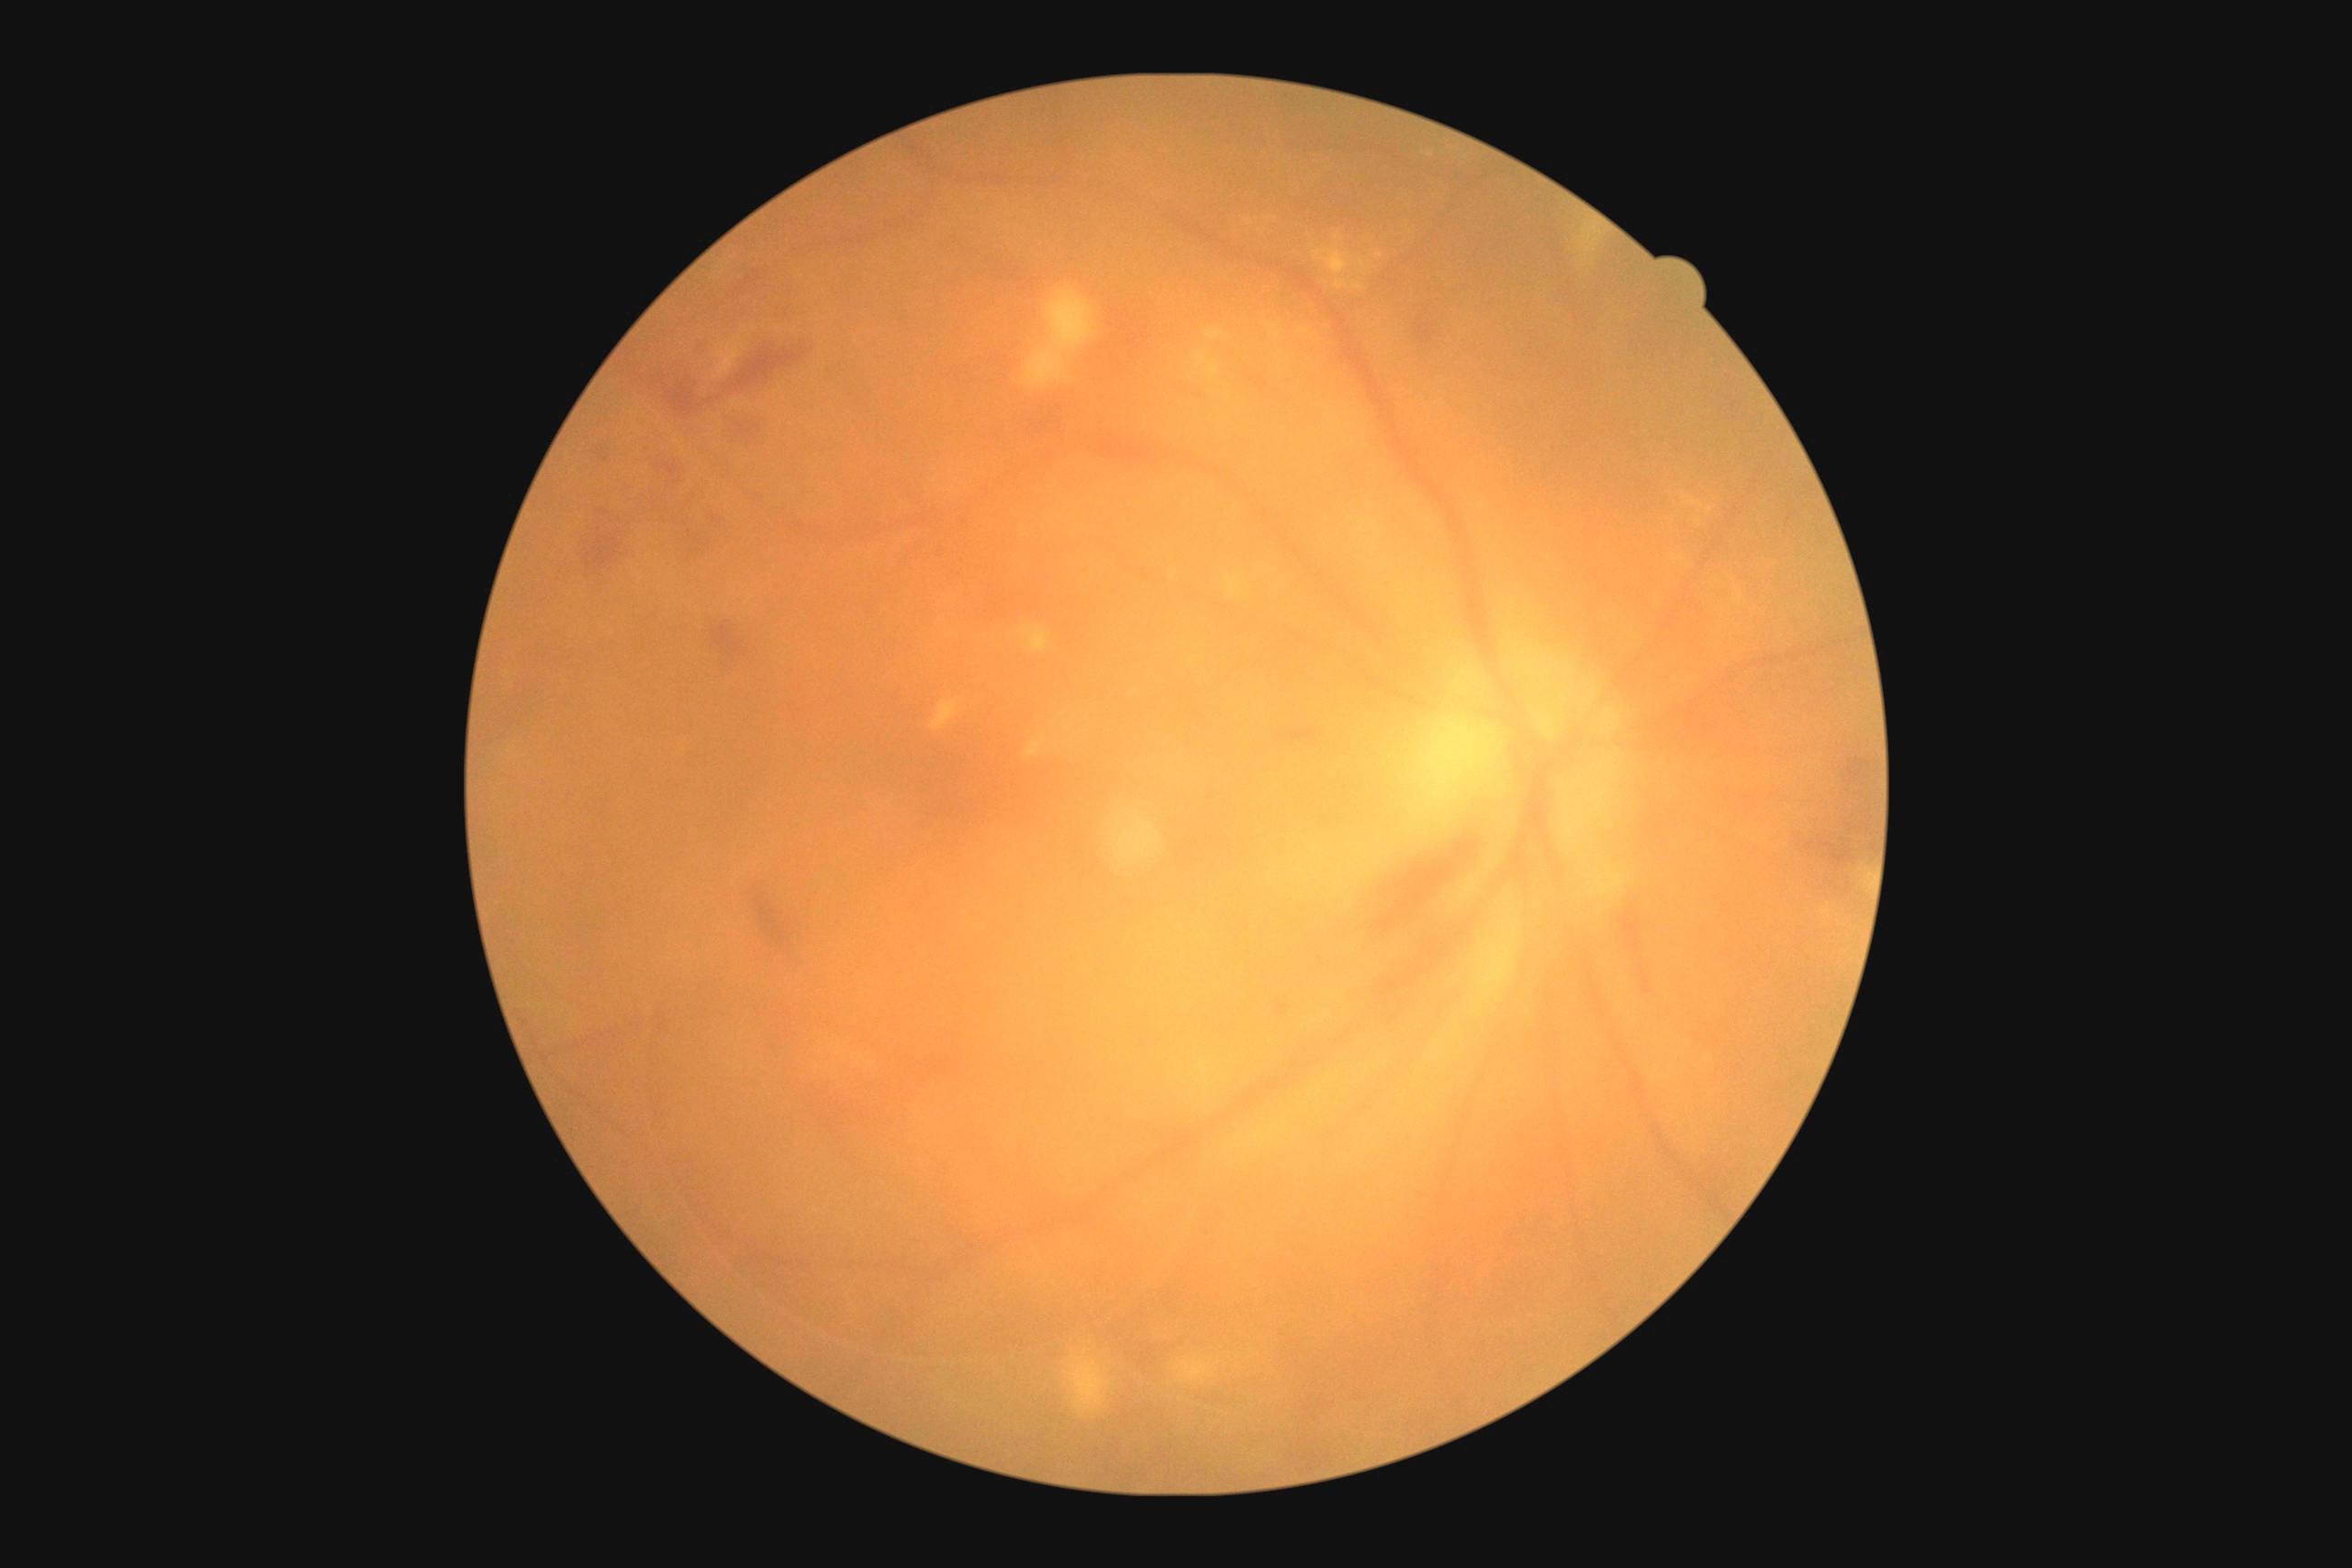 DR grade: 2.